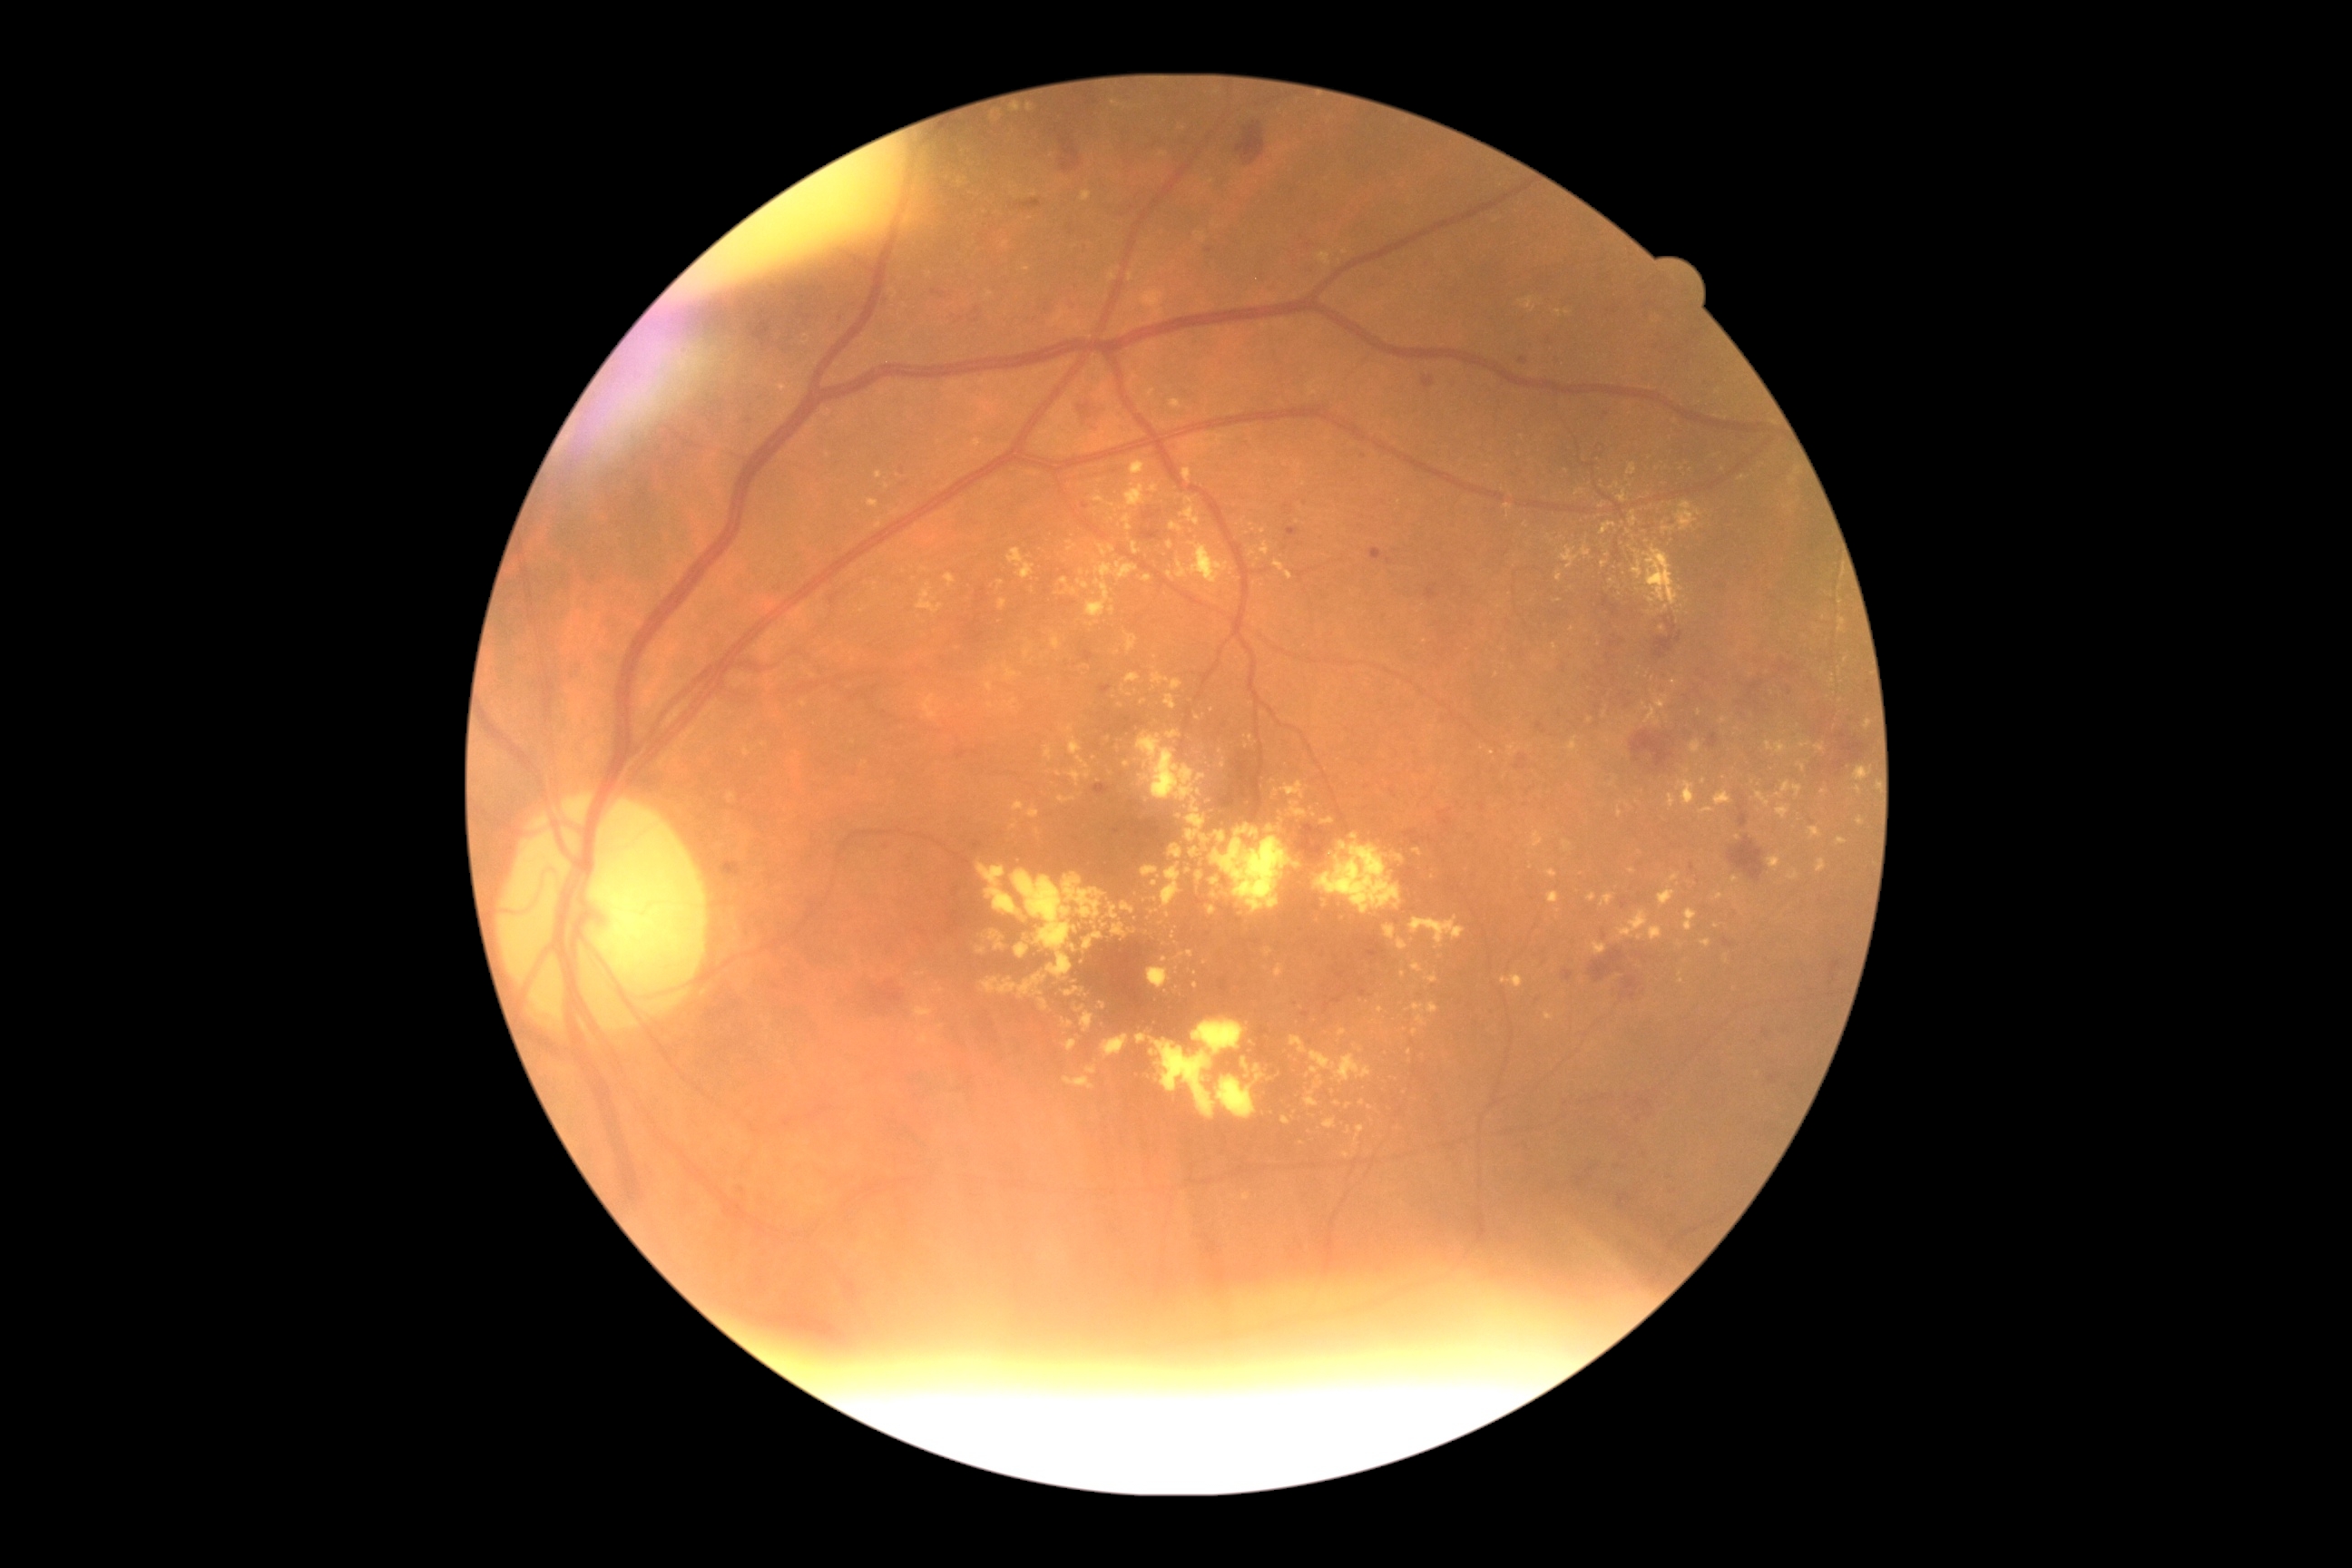

{"partial": true, "dr_grade": 2, "lesions": {"ex": [[1150, 484, 1159, 495], [1289, 801, 1308, 818], [1193, 1021, 1246, 1057], [1776, 741, 1788, 754], [1164, 694, 1177, 710], [1122, 687, 1133, 698], [1618, 807, 1623, 818], [1142, 574, 1152, 583], [1188, 830, 1199, 843], [1188, 798, 1206, 828], [974, 440, 983, 447], [1010, 184, 1019, 190]], "ex_small_centers": [[1611, 582], [1148, 934], [1497, 676], [1196, 986], [1797, 472], [1034, 194], [1609, 556]]}}